Ultra-widefield fundus photograph
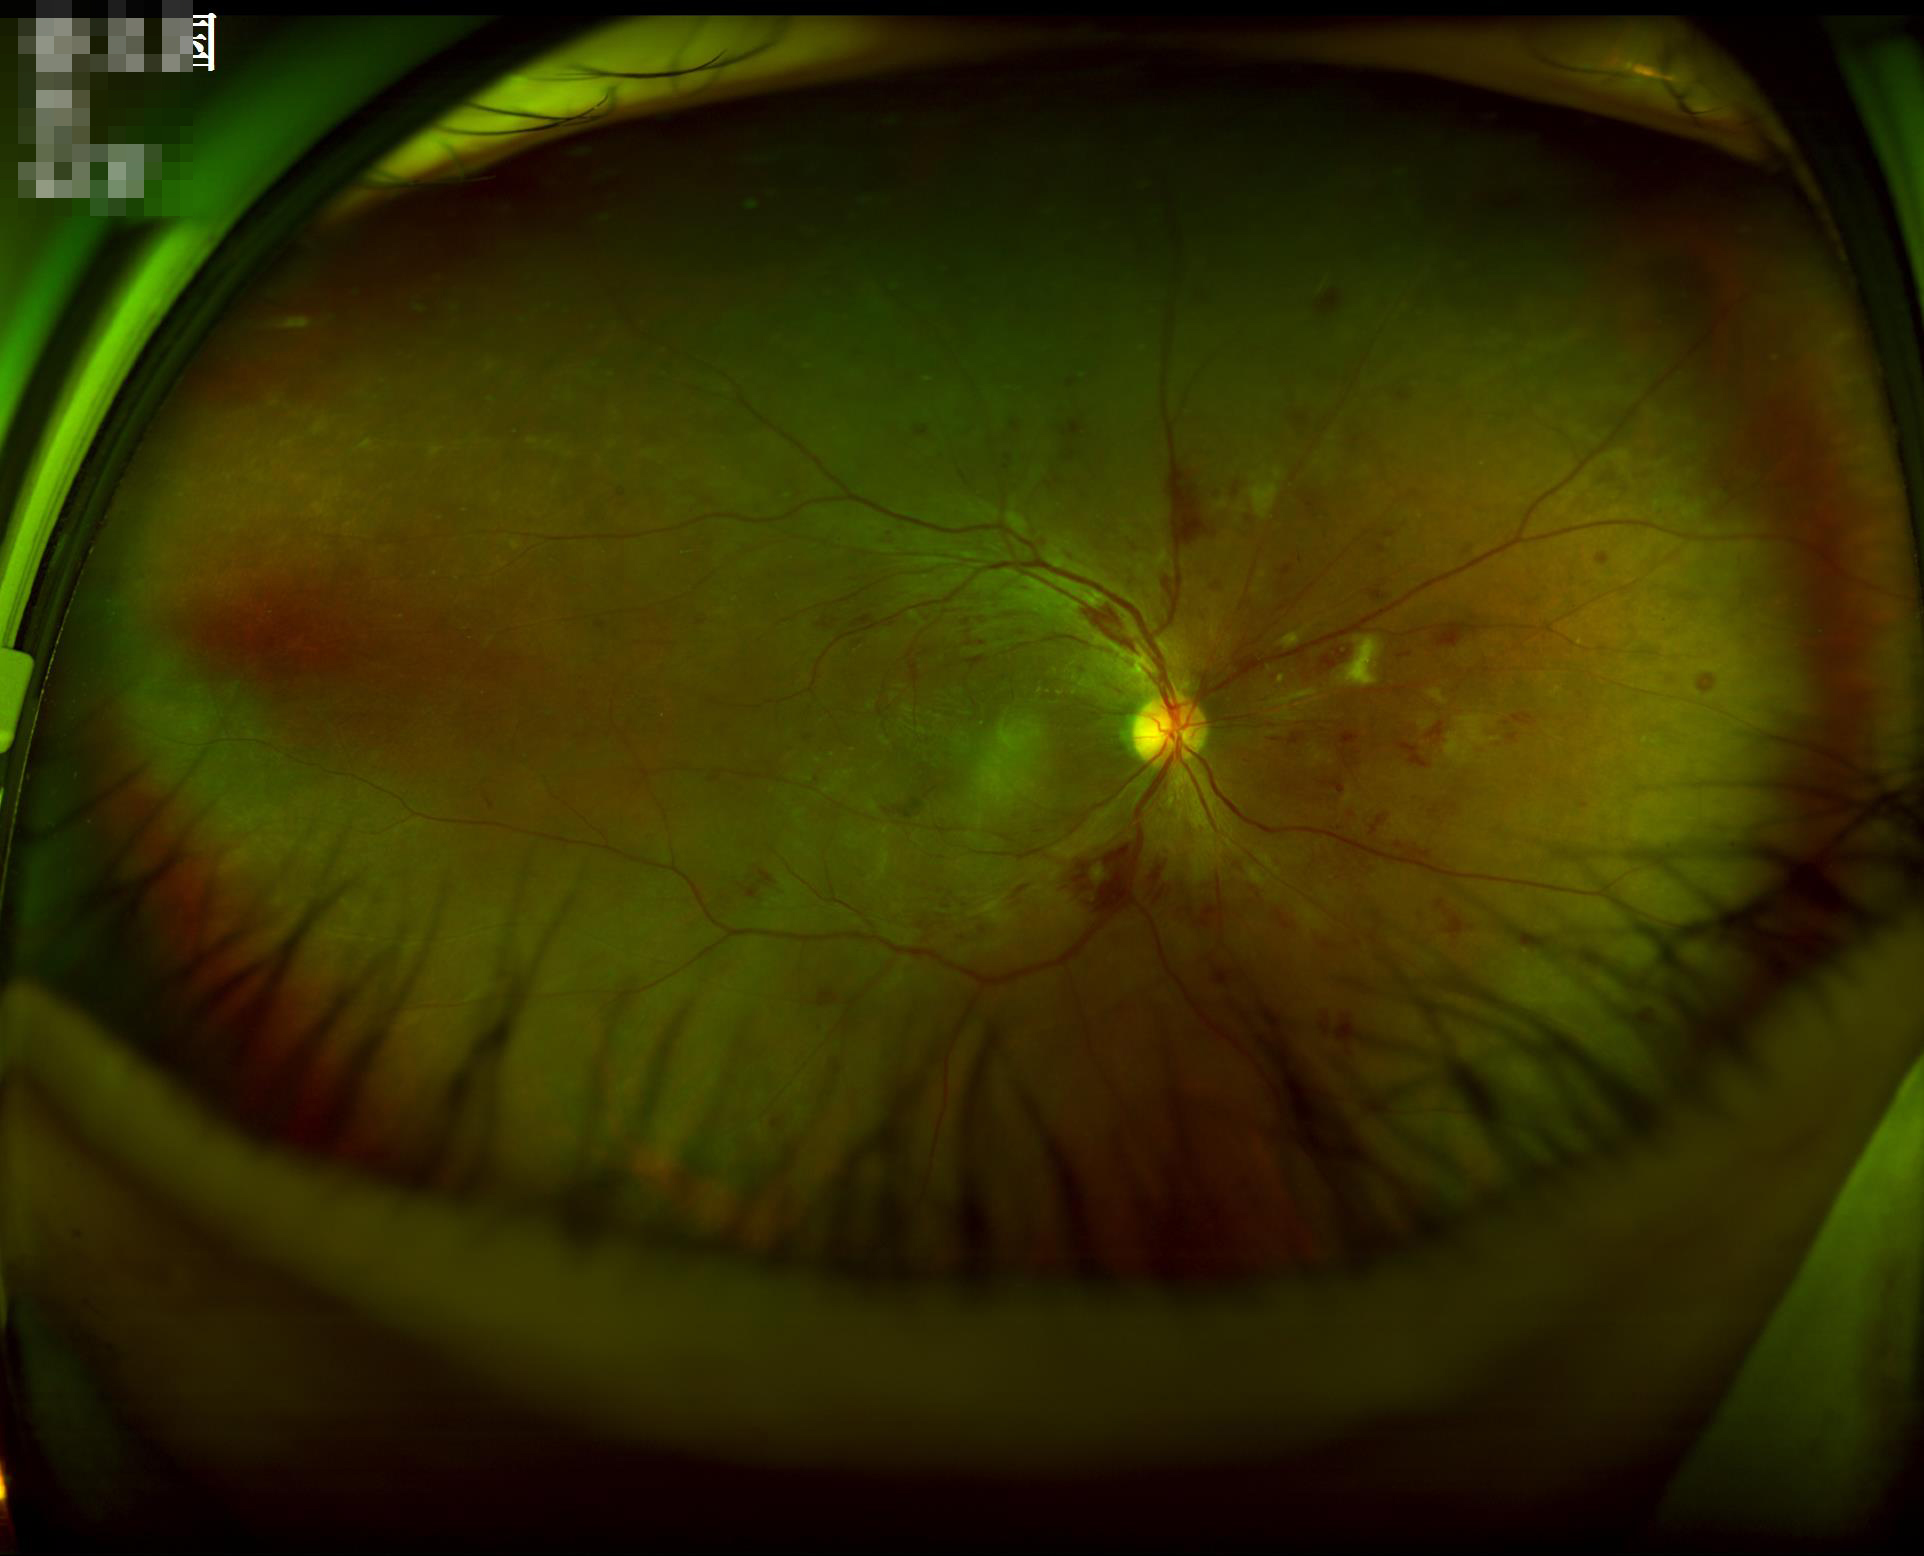

Image quality is adequate for diagnostic use.
Even illumination with no color cast.
No noticeable blur.